Color fundus image
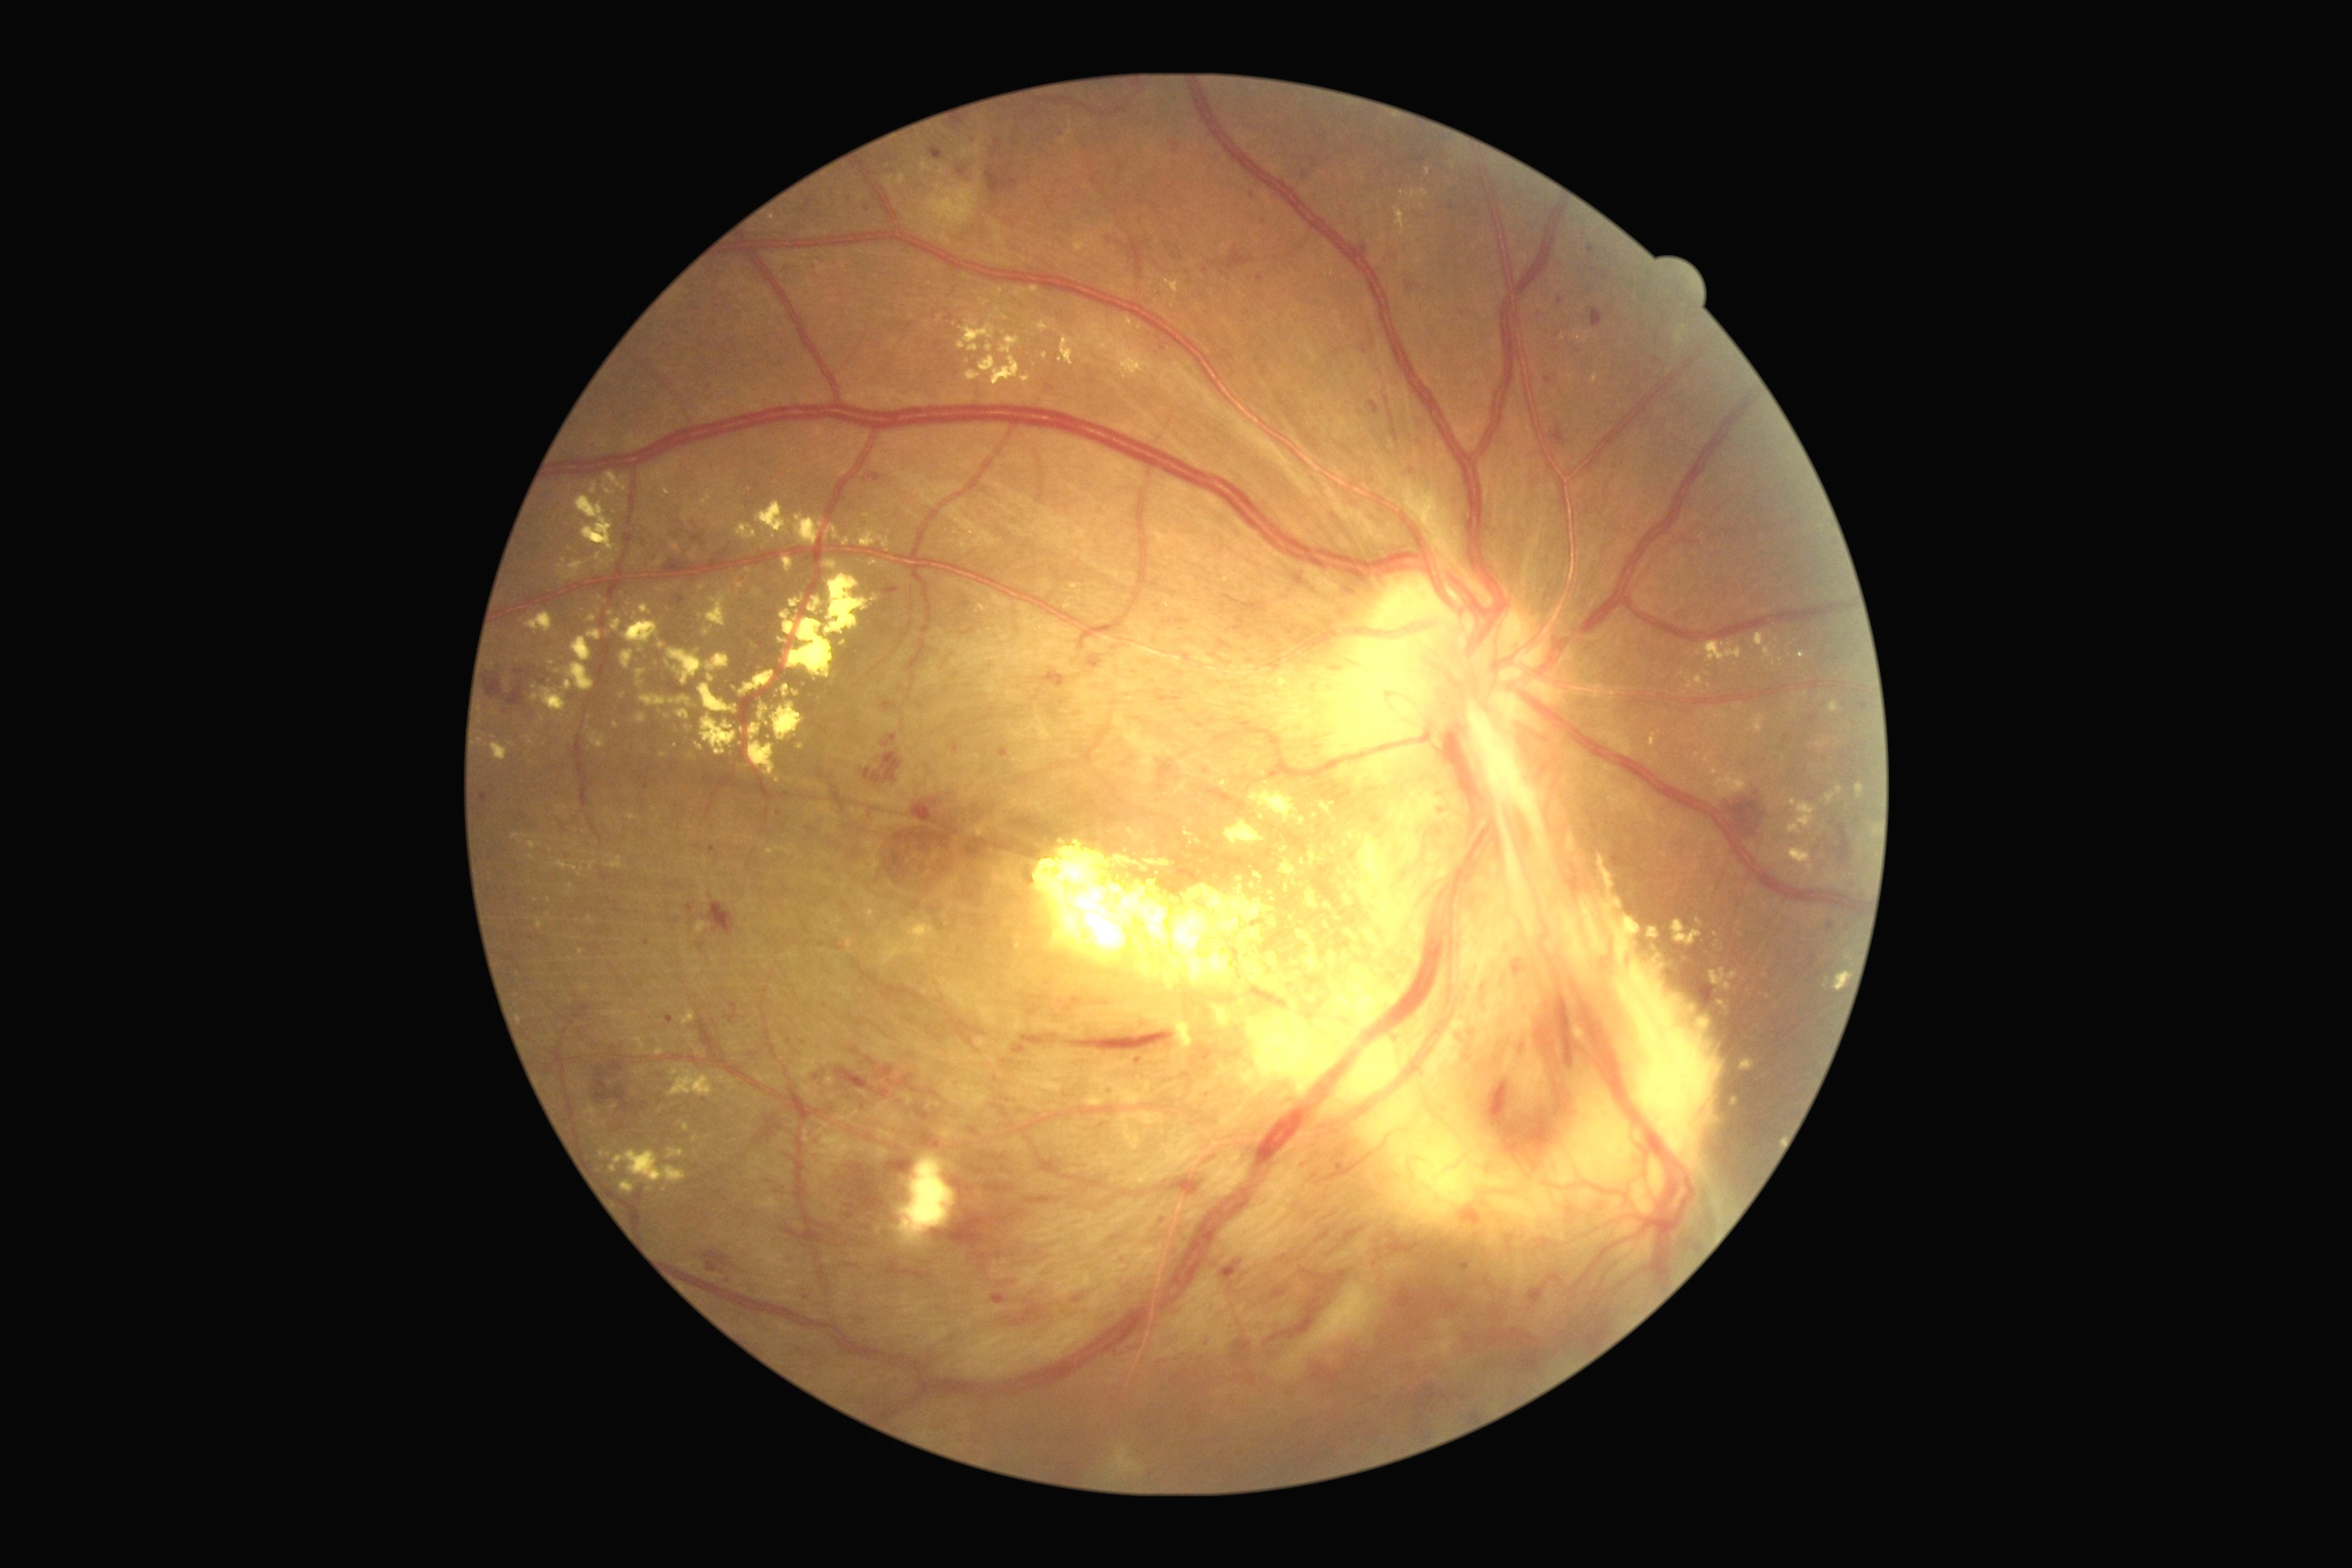

DR grade: PDR (4) — neovascularization and/or vitreous/pre-retinal hemorrhage
Lesions identified (partial list):
EXs (more not shown): region(912, 923, 932, 934) | region(1308, 850, 1326, 867) | region(1409, 190, 1427, 199) | region(1070, 585, 1079, 591) | region(1649, 734, 1656, 747) | region(1014, 286, 1043, 299) | region(667, 649, 730, 685) | region(612, 620, 623, 632) | region(1788, 848, 1814, 874) | region(738, 765, 750, 770) | region(660, 752, 667, 760) | region(600, 1150, 612, 1159) | region(957, 322, 995, 351)
Smaller EXs around 1681:674 | 669:664 | 748:571 | 1190:822 | 550:916 | 650:1189